Diabetic retinopathy graded by the modified Davis classification.
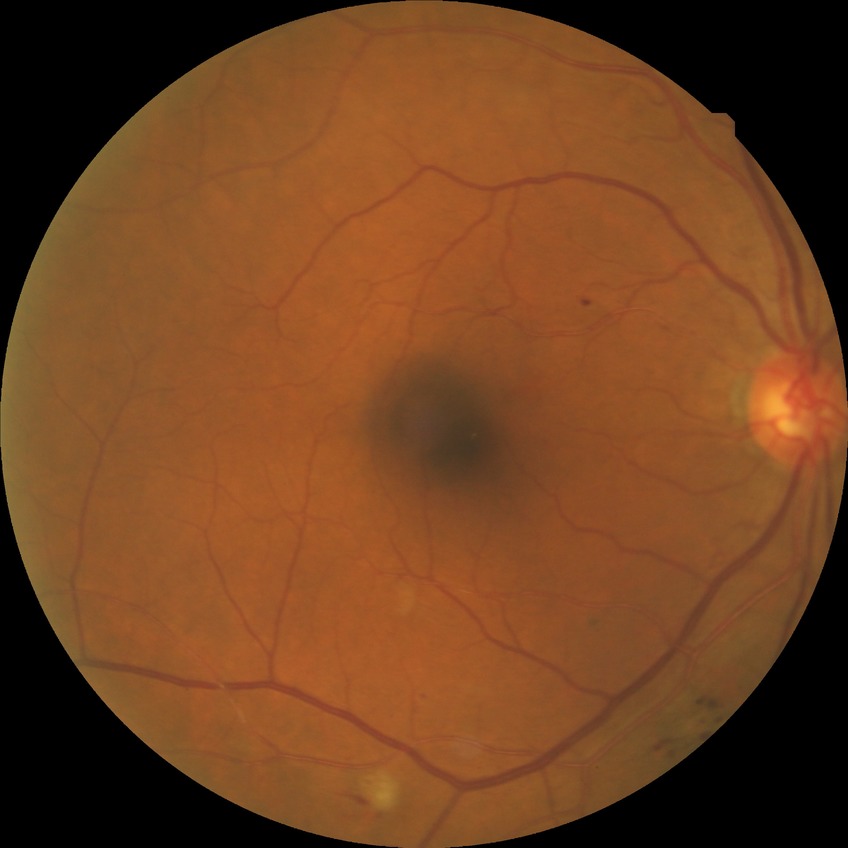 Diabetic retinopathy (DR): pre-proliferative diabetic retinopathy (PPDR).